Captured on a Topcon TRC-NW400 fundus camera · non-mydriatic acquisition:
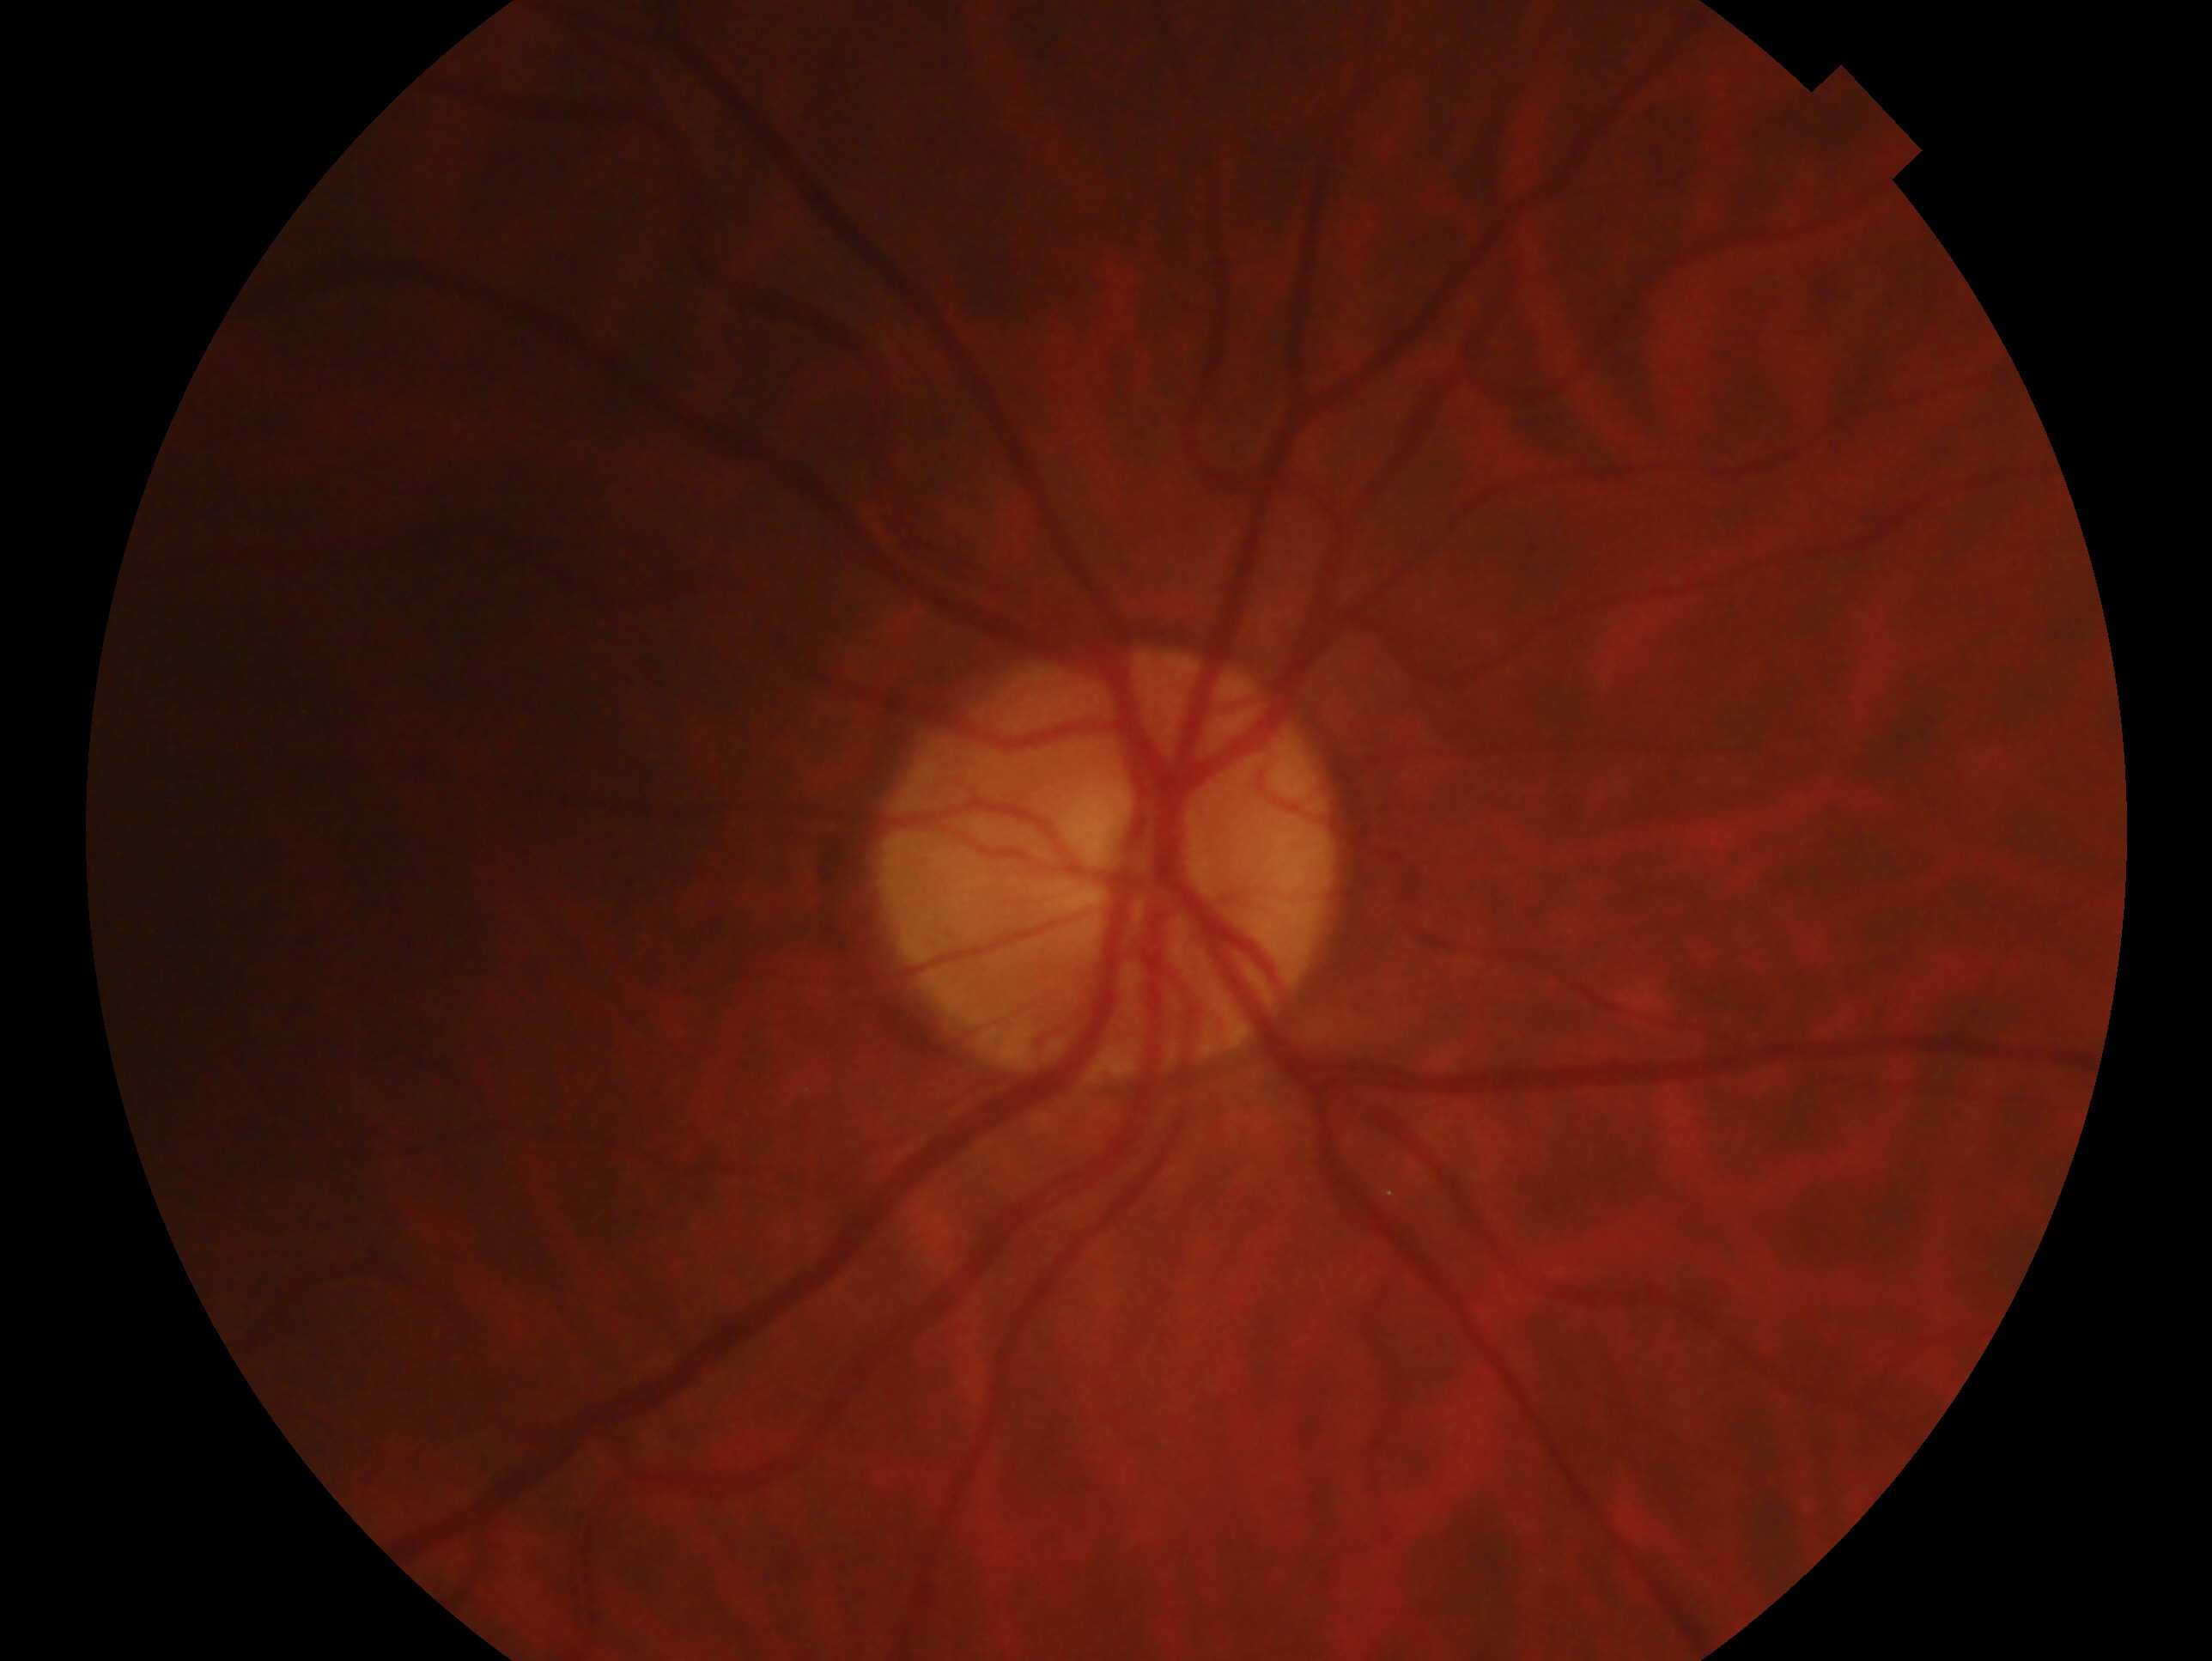

Assessment — no glaucoma.
The image shows the oculus dexter.